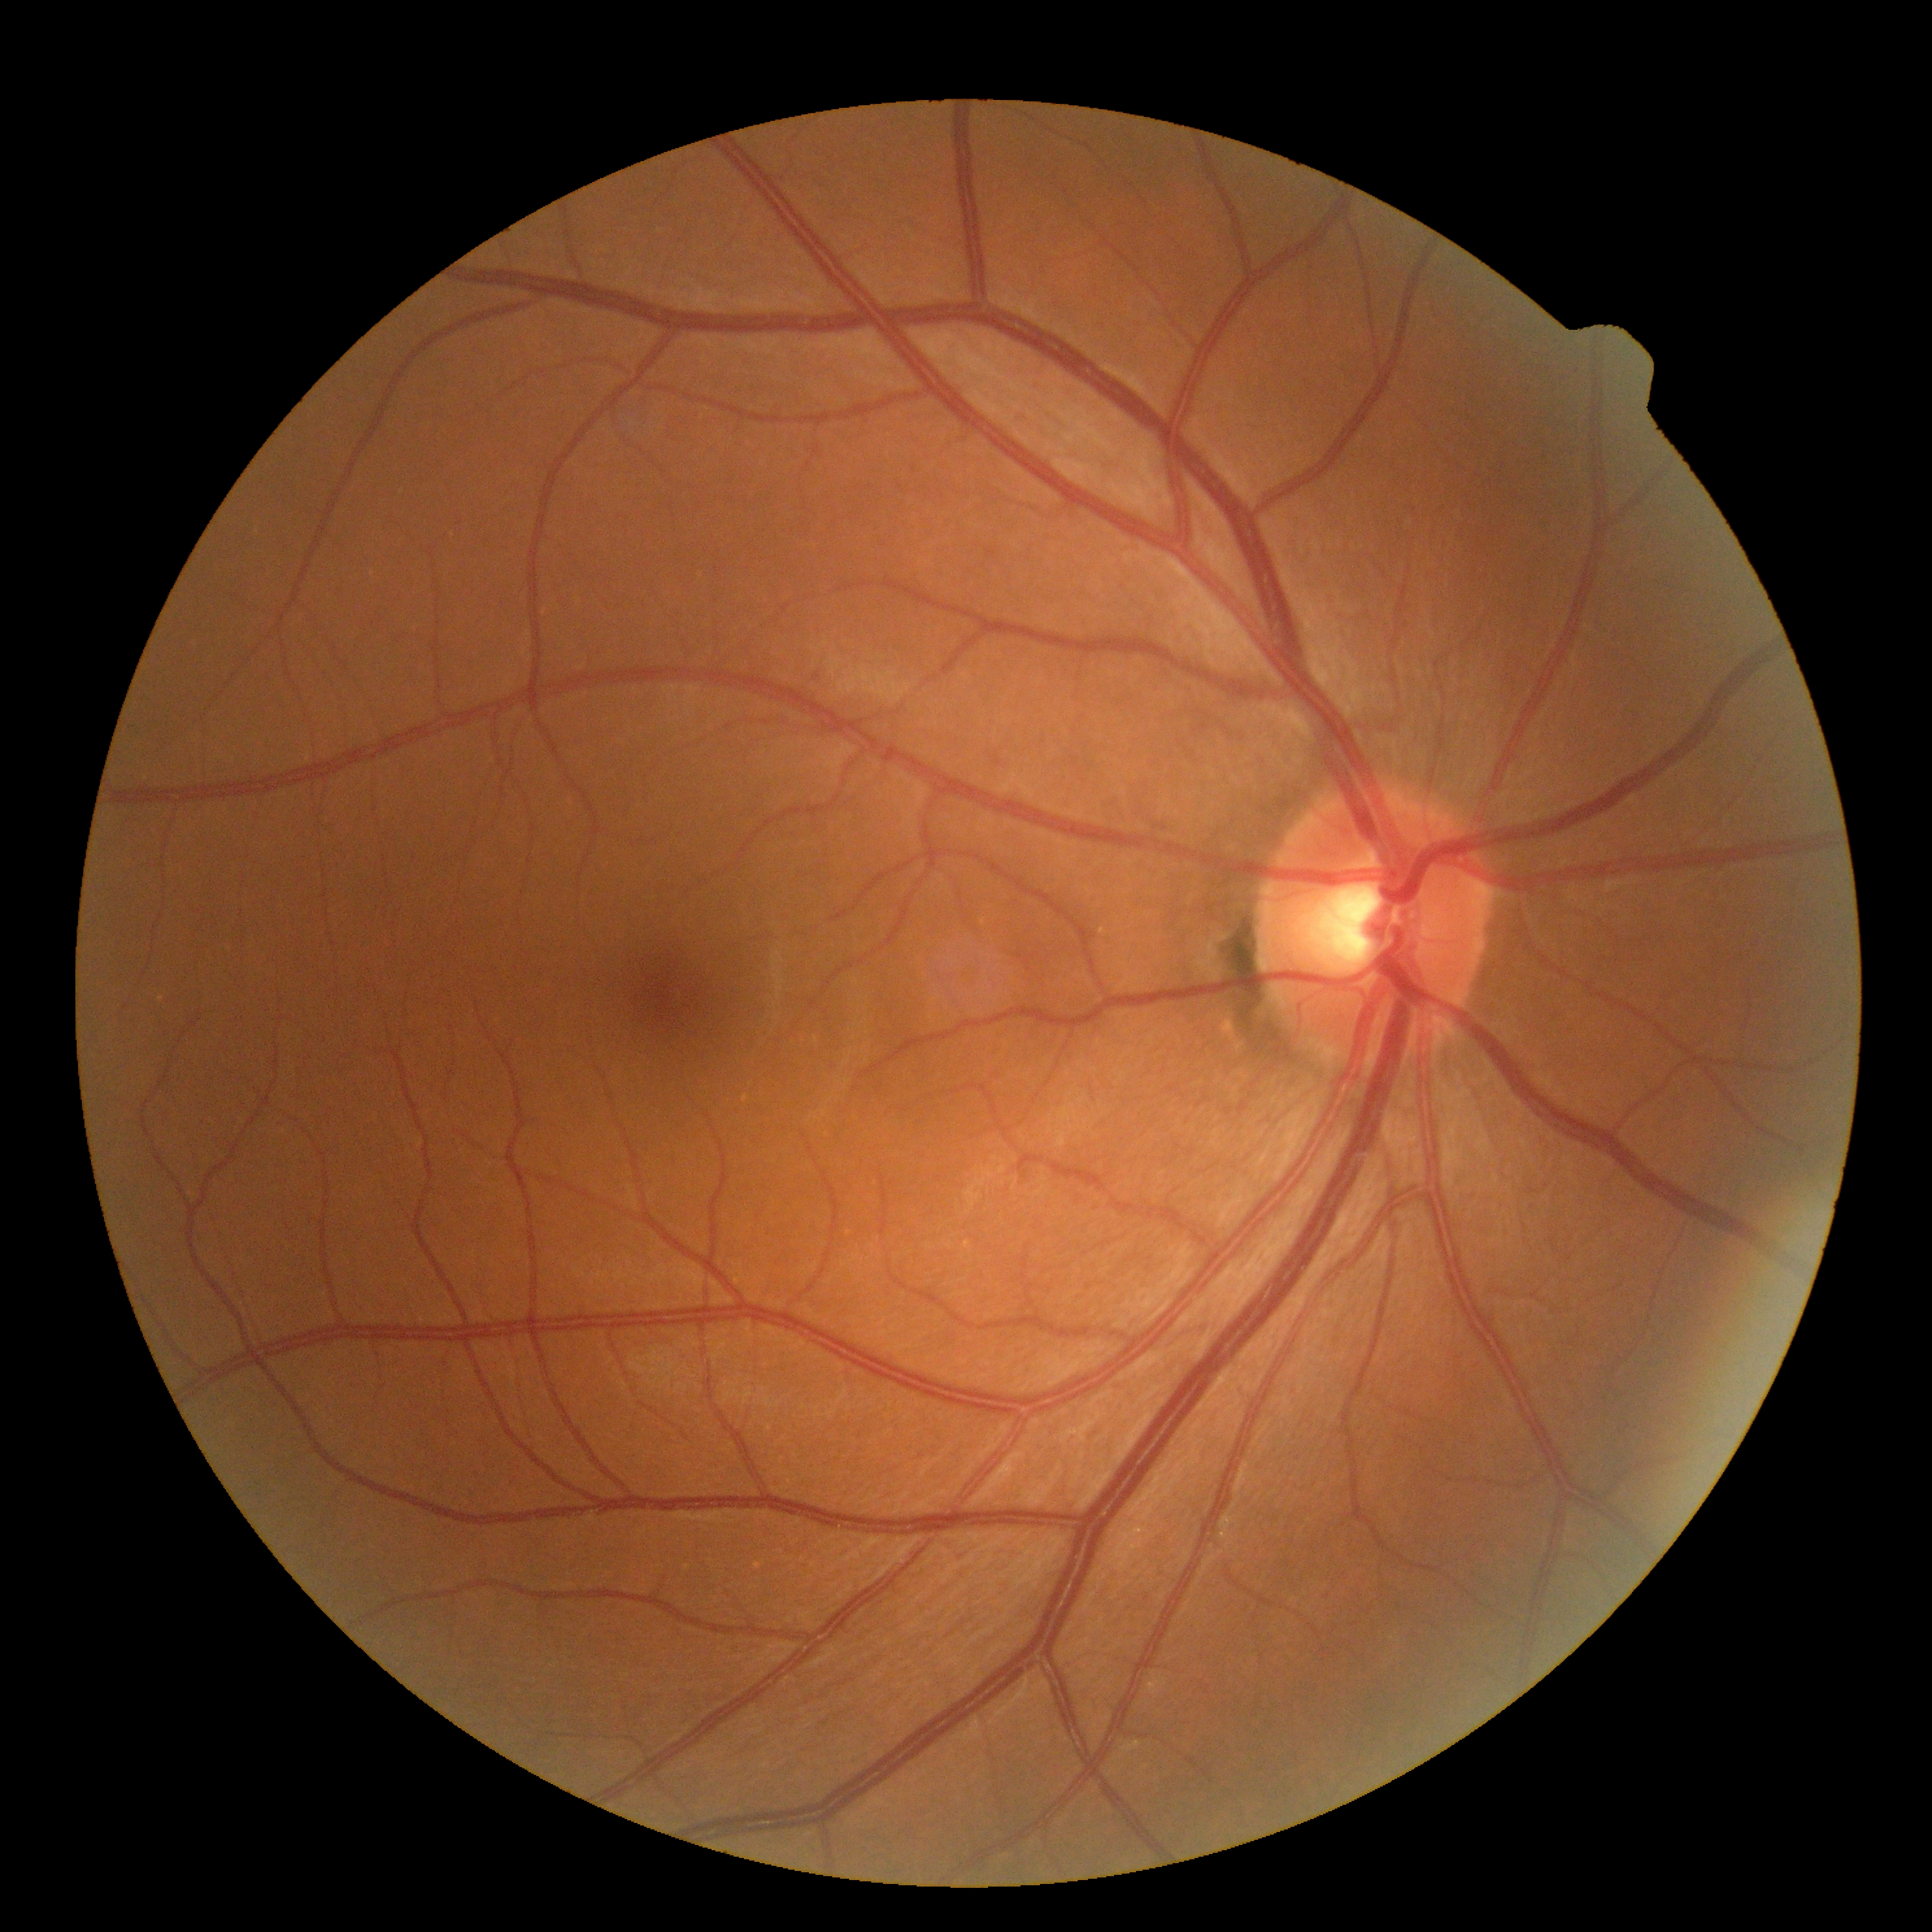 Annotations:
– DR impression: no DR findings
– diabetic retinopathy grade: 0 (no apparent retinopathy)